Wide-field contact fundus photograph of an infant. Image size 1240x1240:
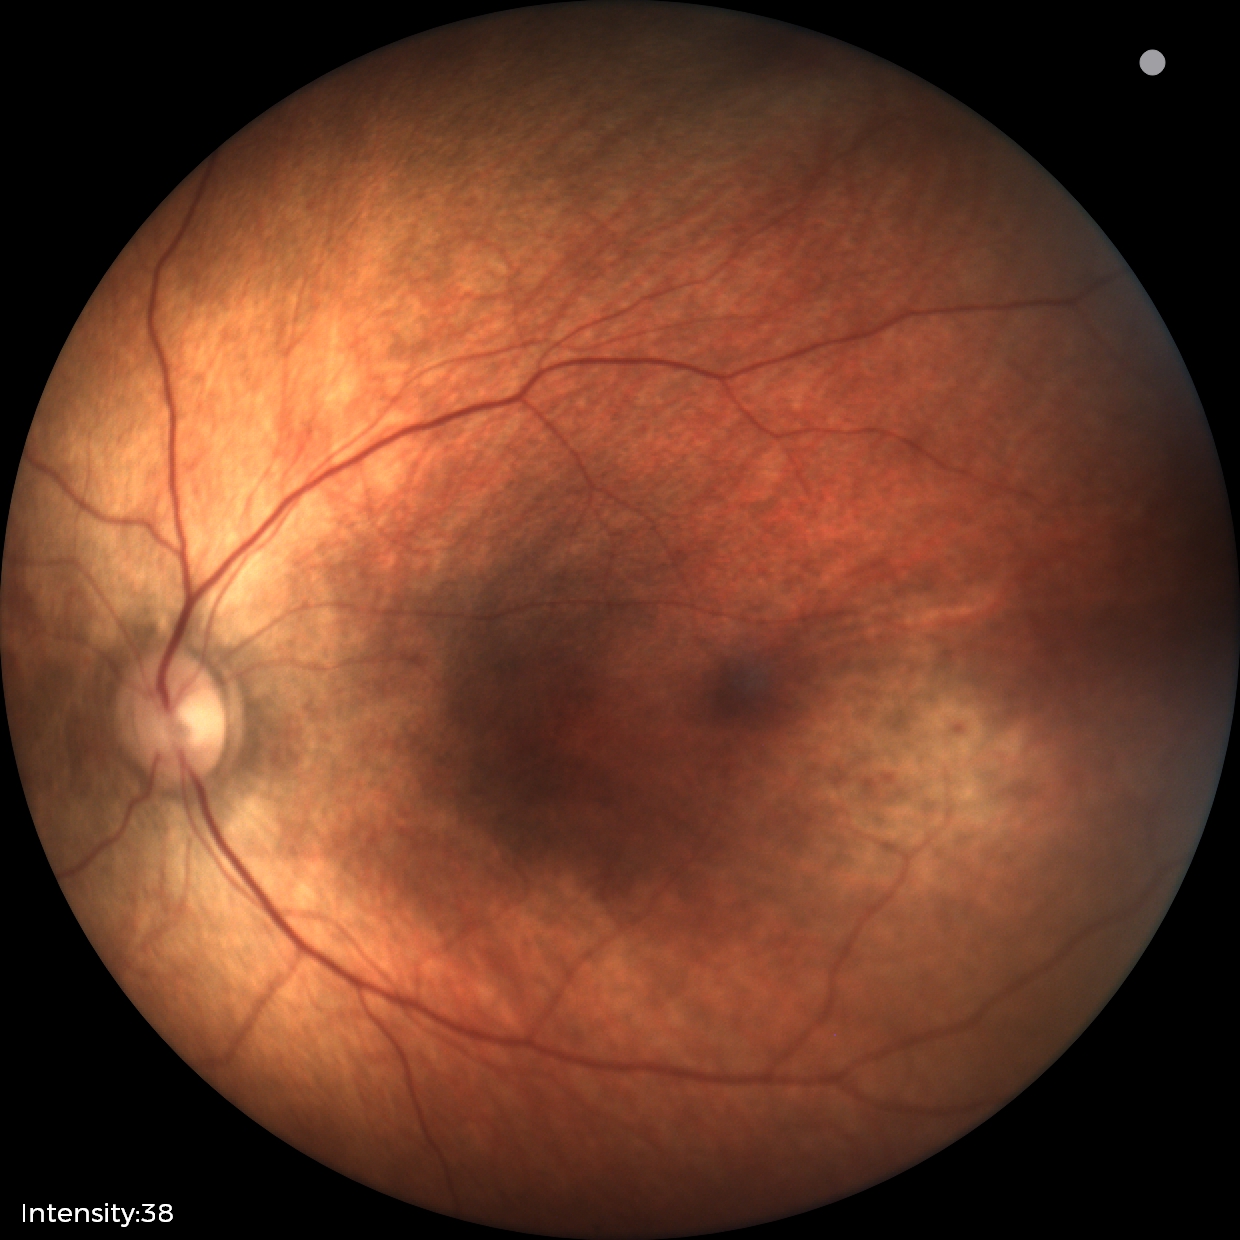
Impression: normal retinal appearance.